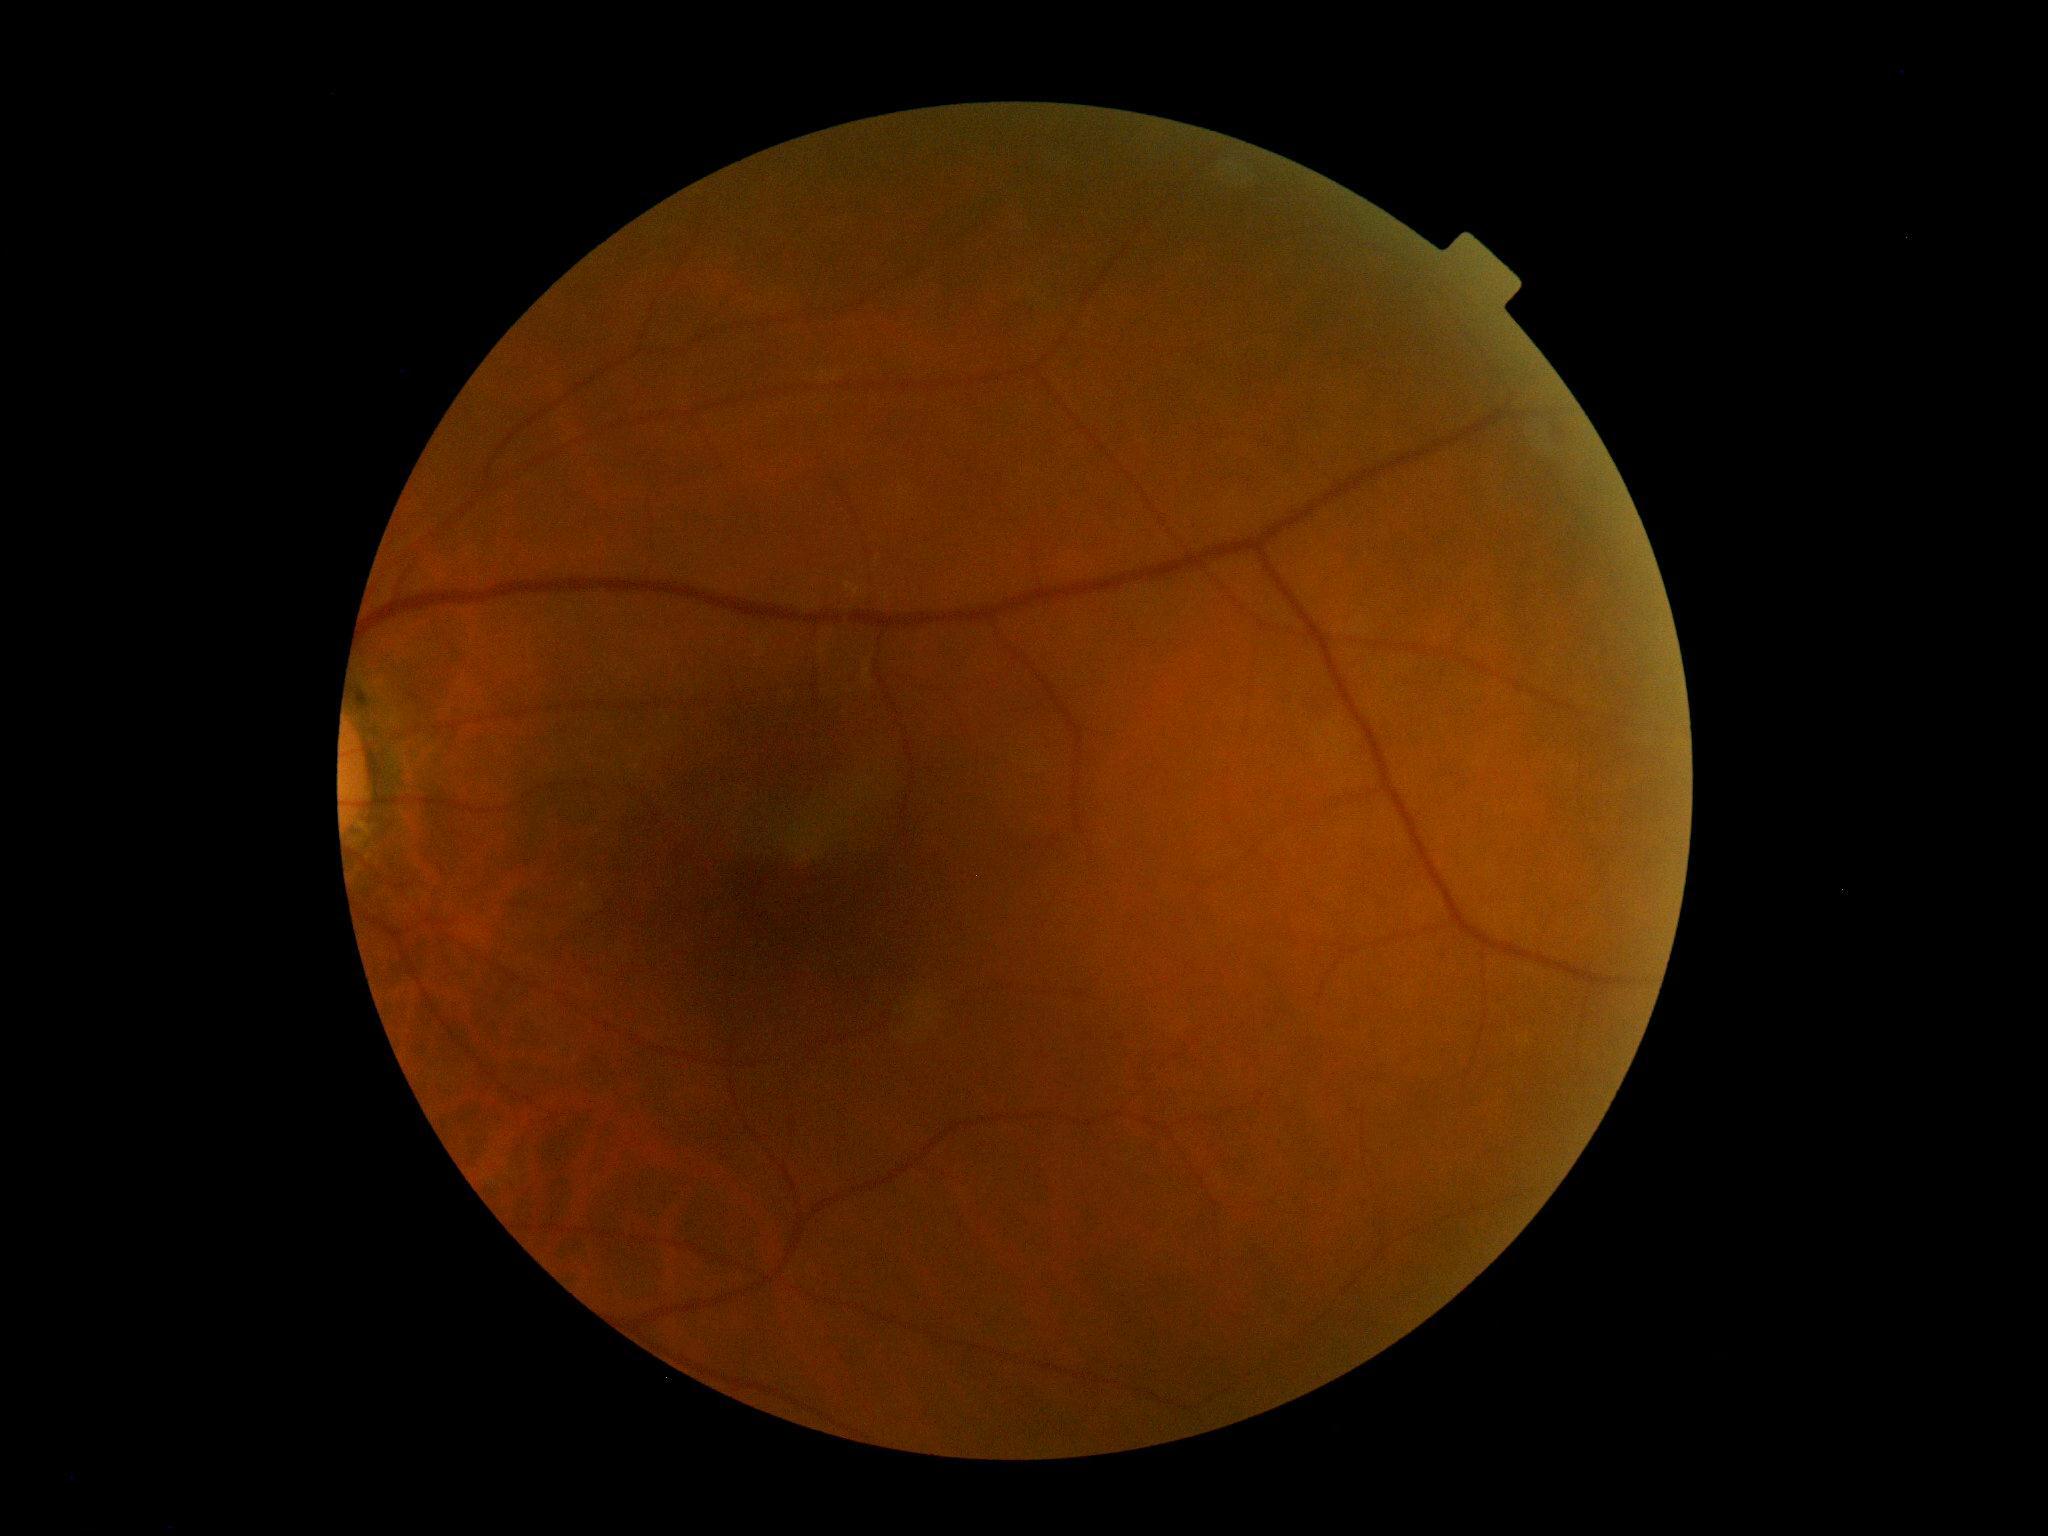 DR: no apparent diabetic retinopathy (grade 0).